Captured on a Bosch fundus camera — 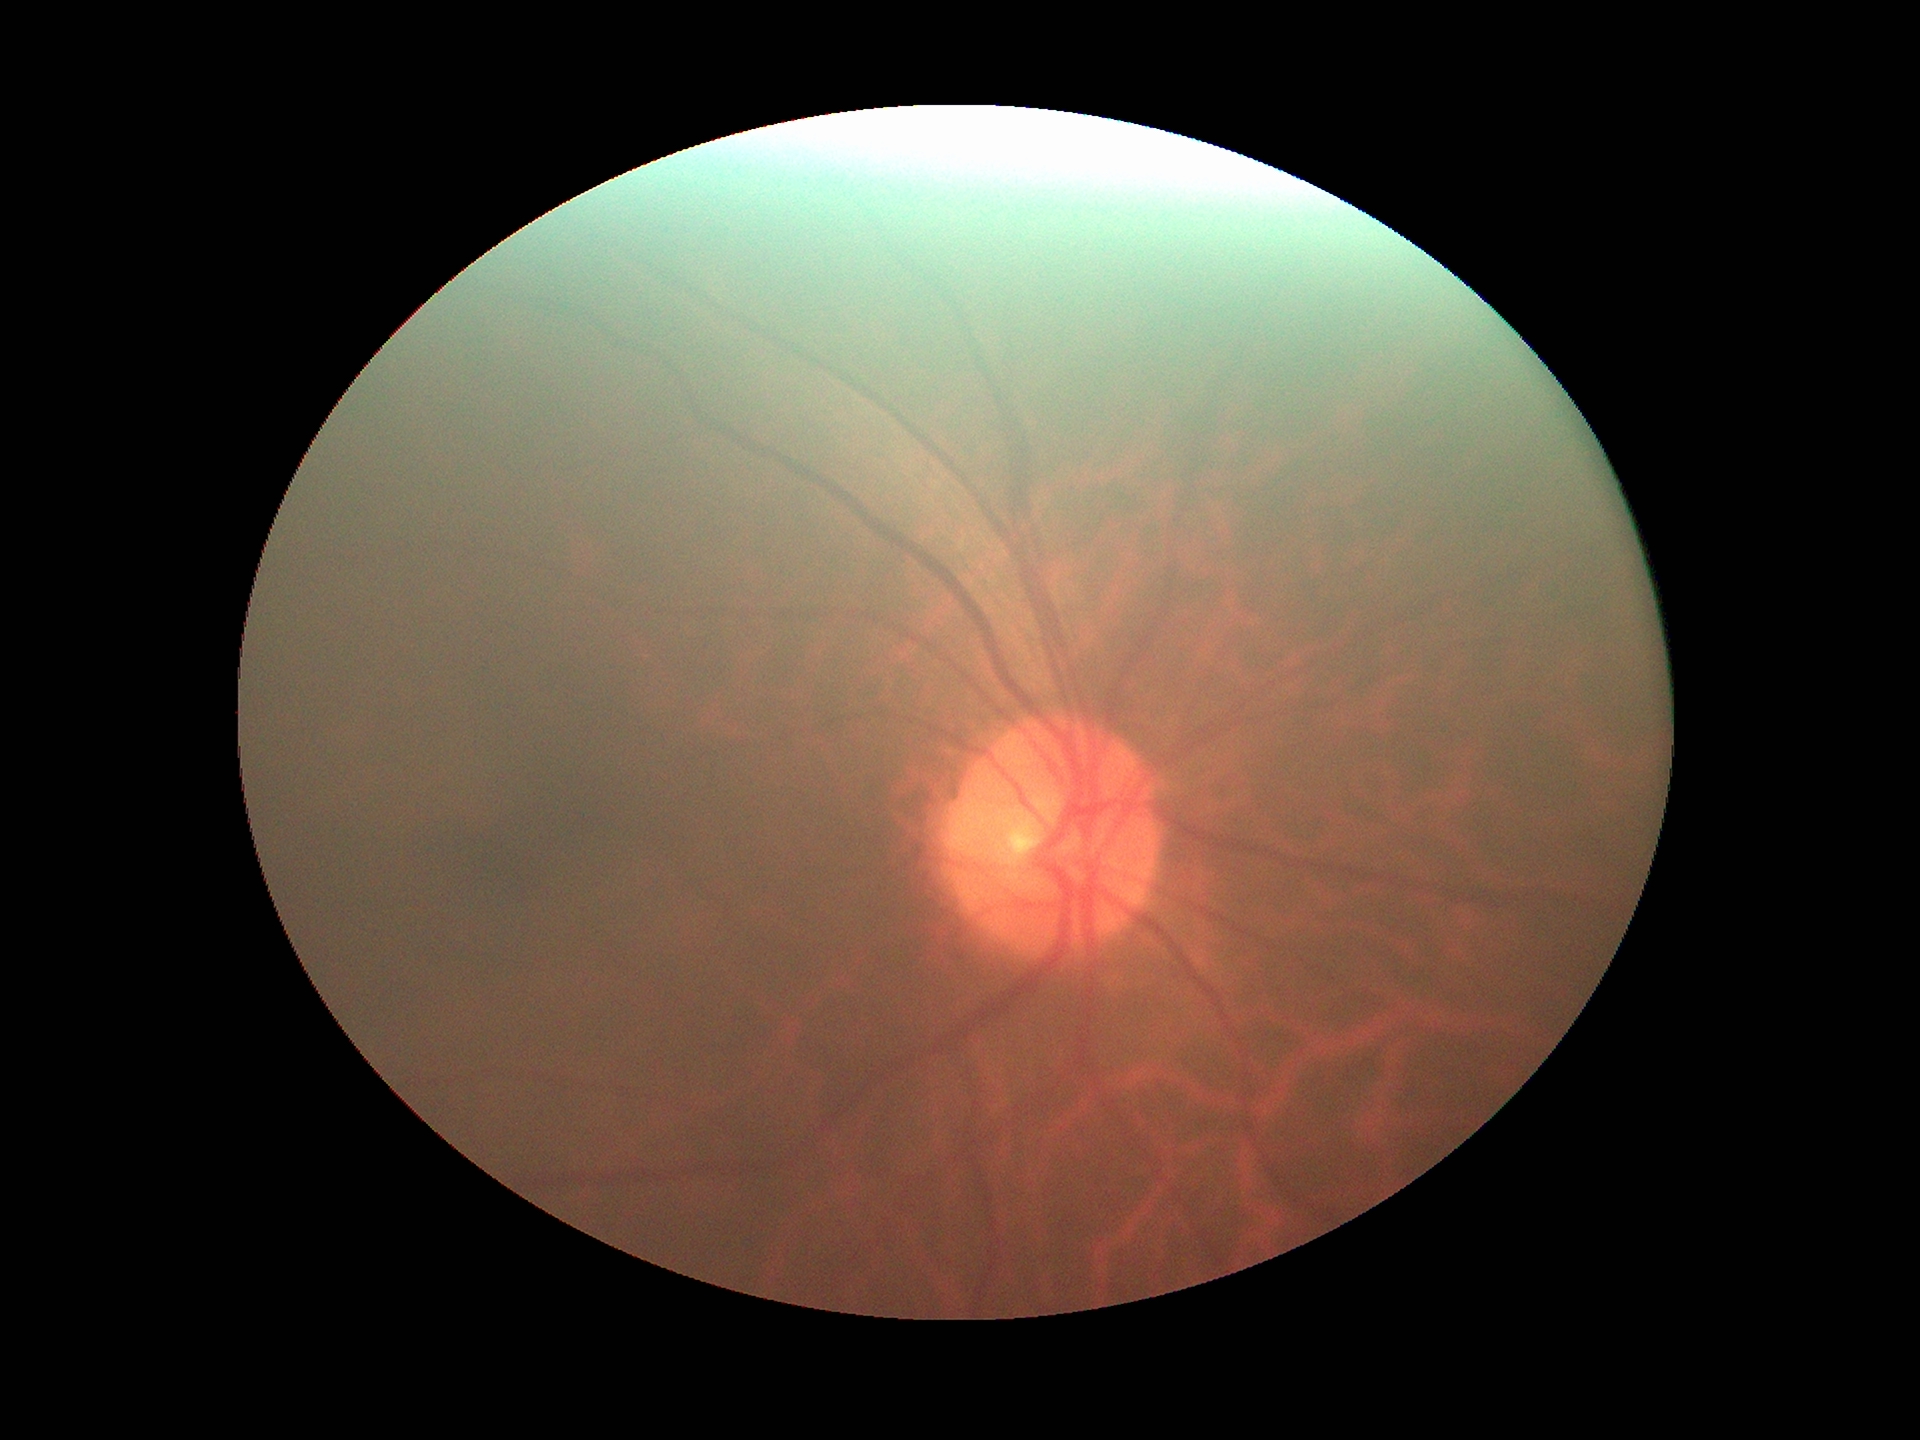
Glaucoma decision: negative (one of five ophthalmologists flagged glaucoma suspect).
Vertical CDR: 0.48.